848x848px · FOV: 45 degrees · posterior pole photograph · camera: NIDEK AFC-230 · Davis DR grading:
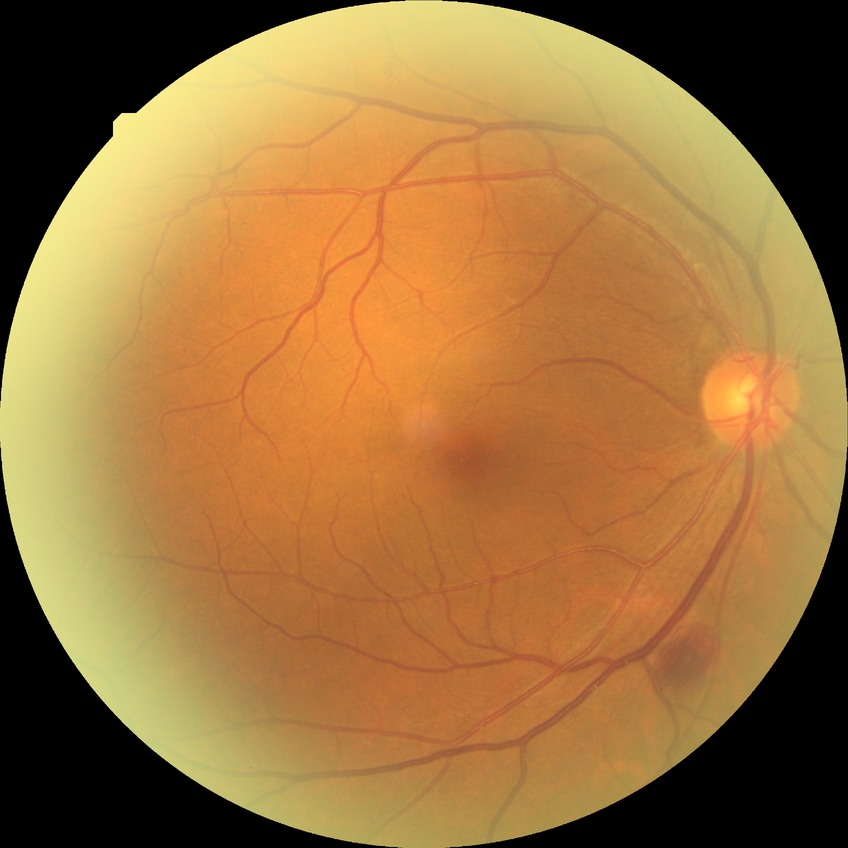
retinopathy grade@simple diabetic retinopathy, DR class@non-proliferative diabetic retinopathy.